Camera: NIDEK AFC-230. 848 by 848 pixels. Without pupil dilation. Posterior pole color fundus photograph.
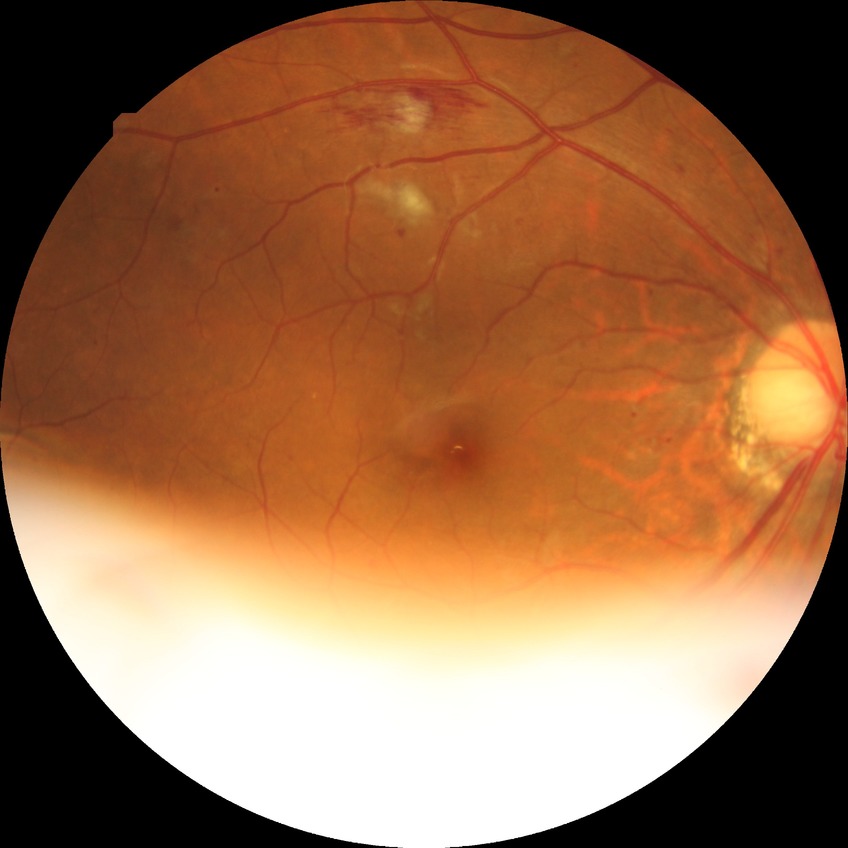
diabetic retinopathy (DR): PPDR (pre-proliferative diabetic retinopathy).